Color fundus image · 1932x1916 · 45-degree field of view:
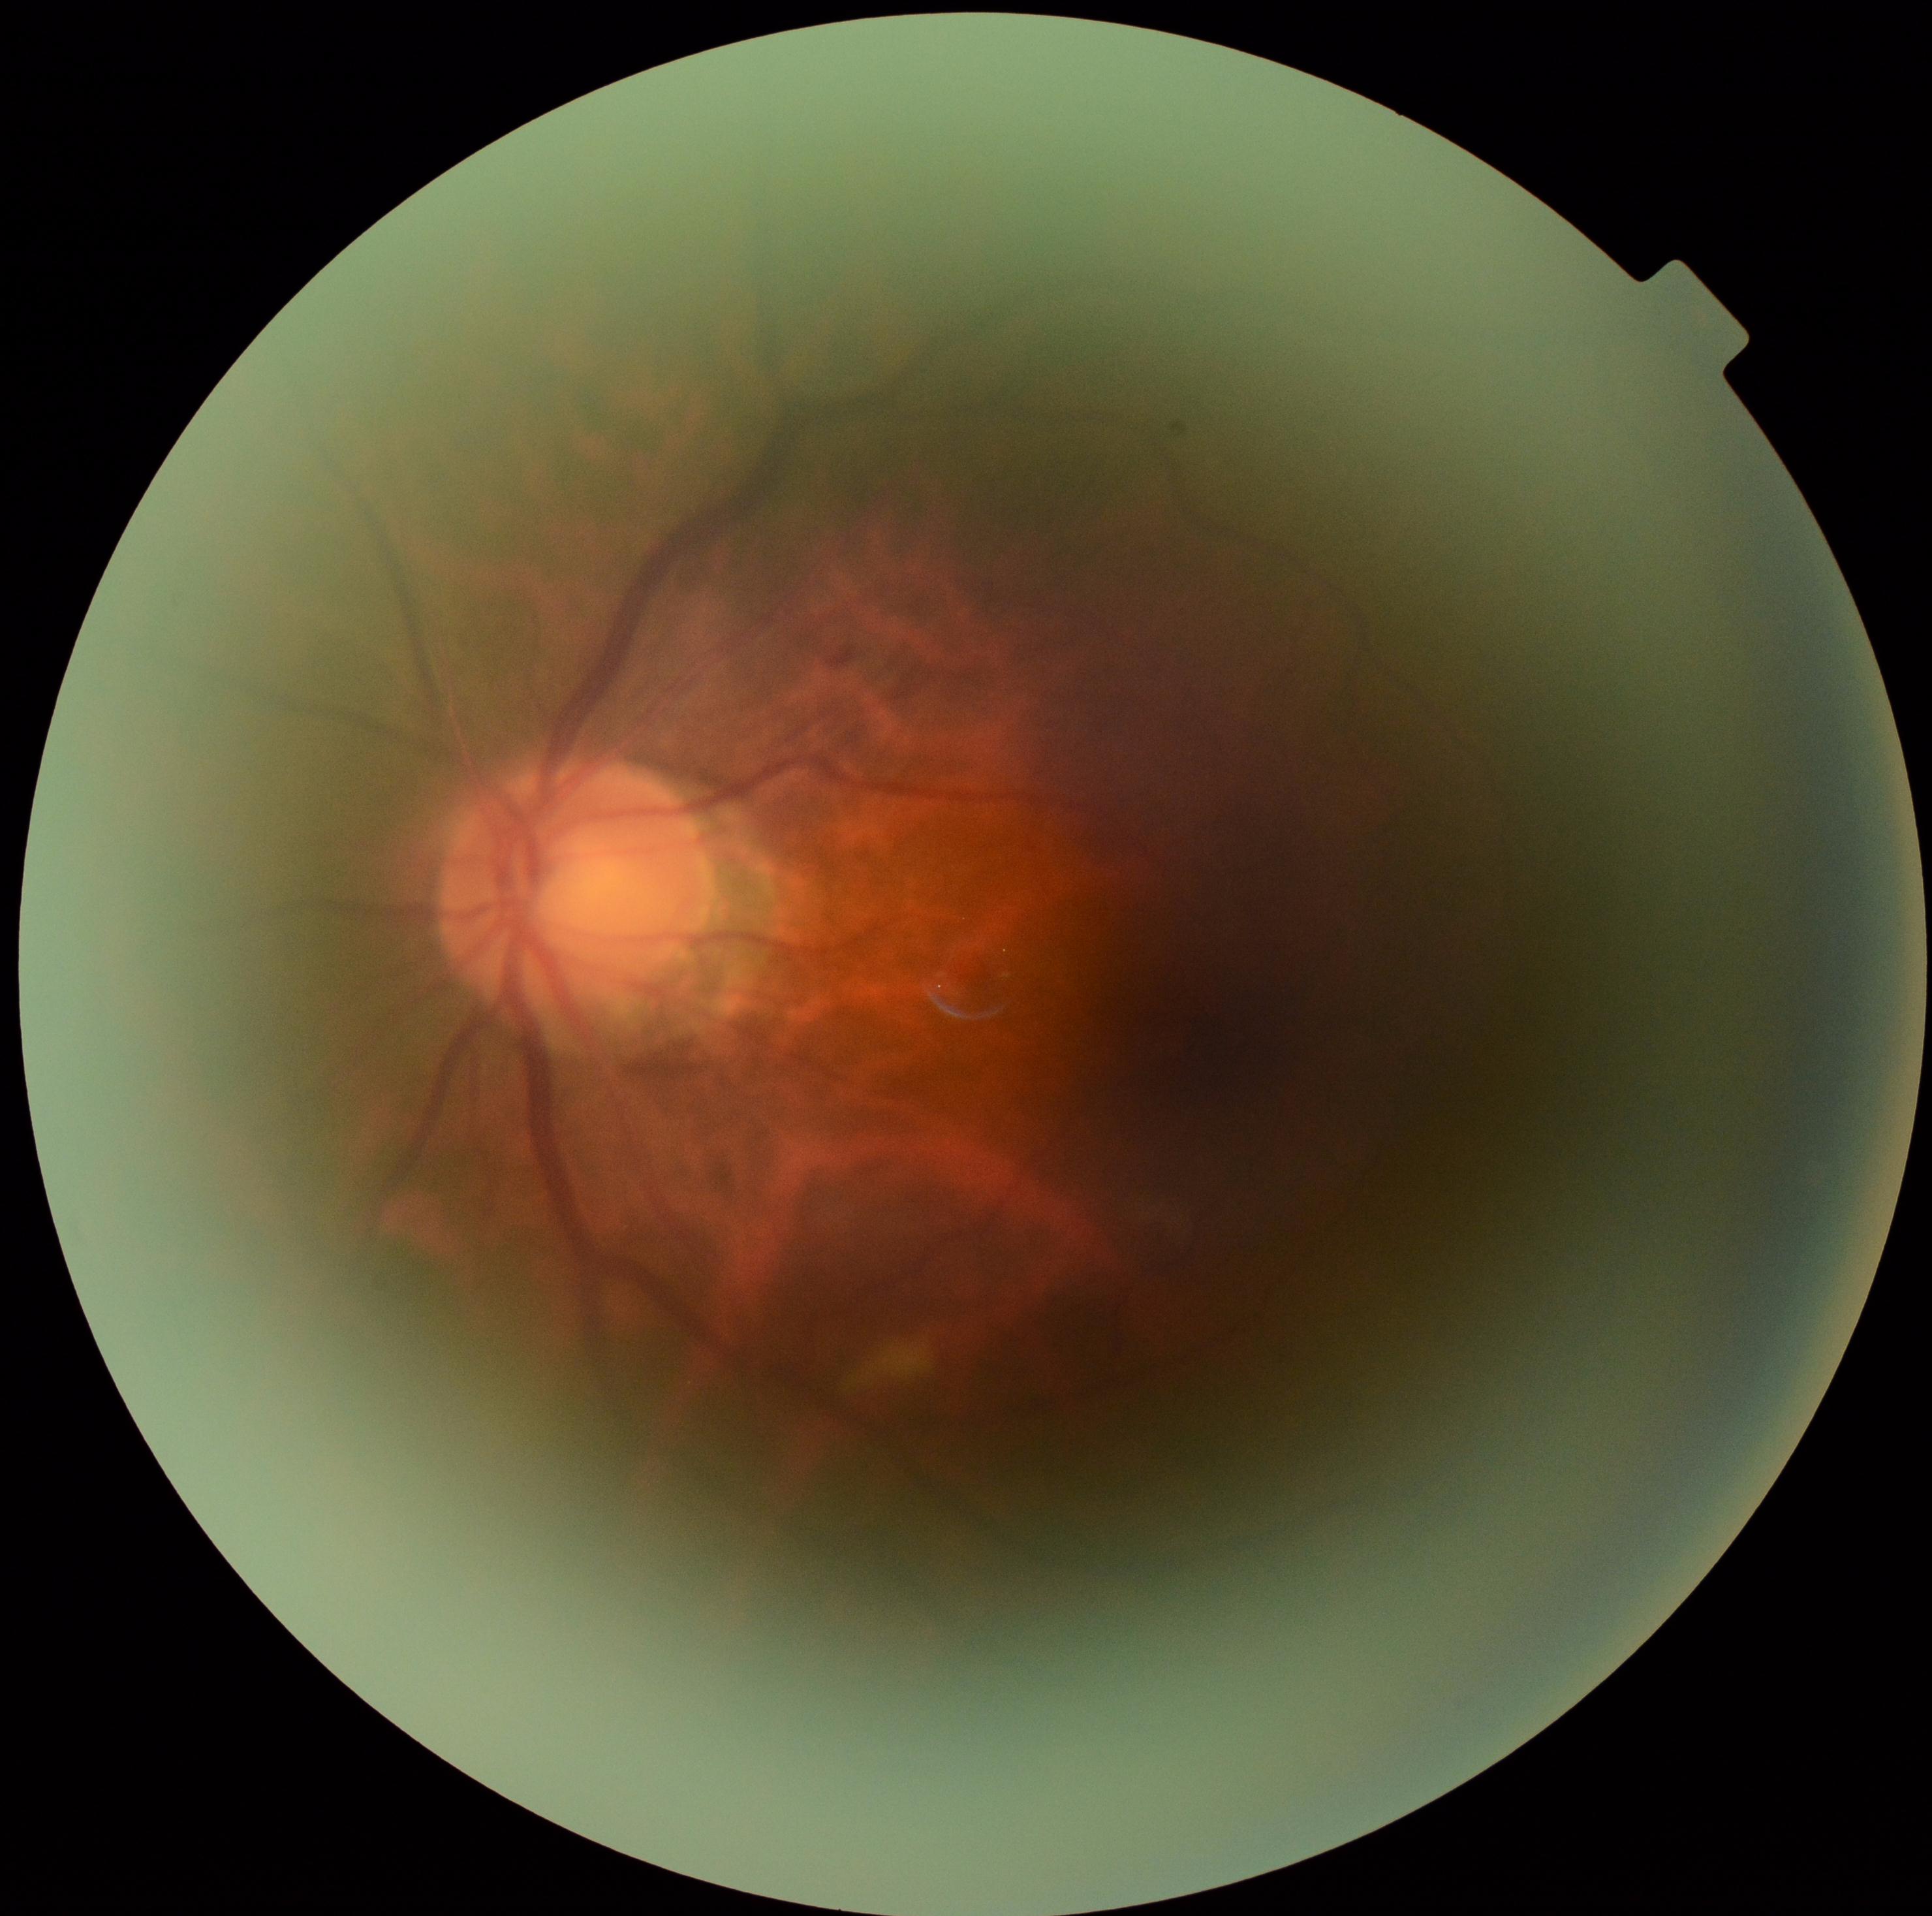 DR: grade 2.